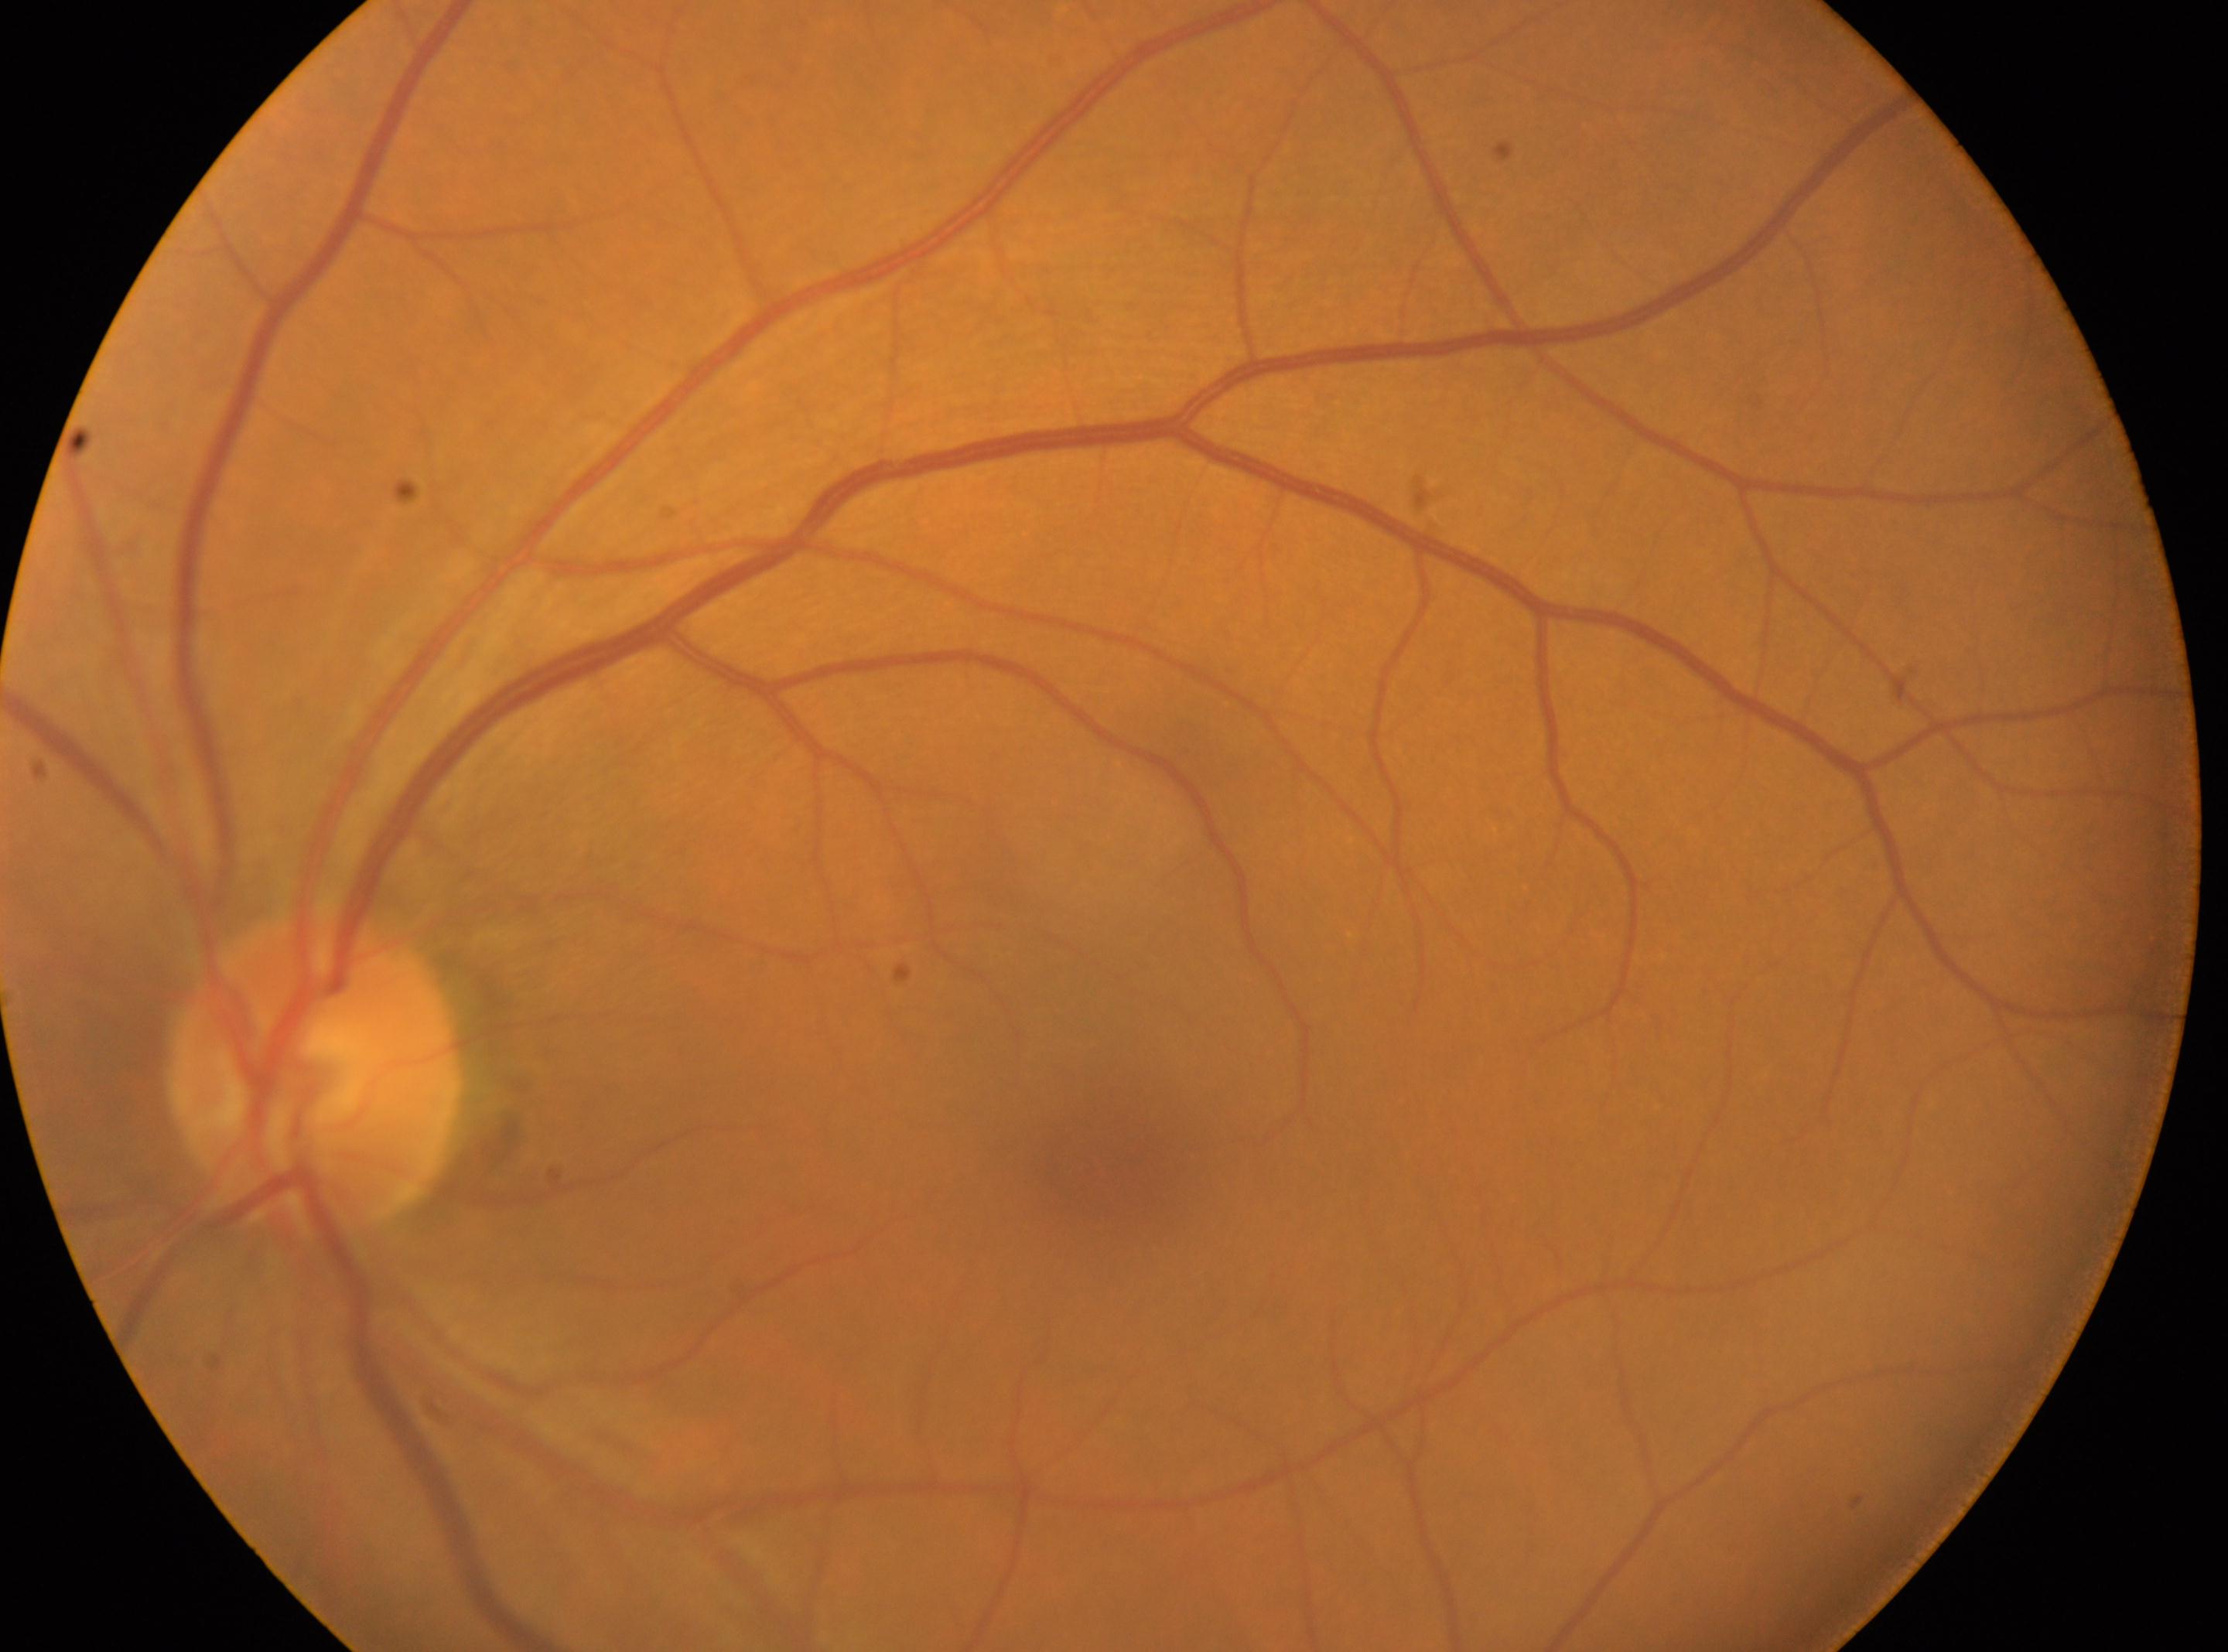 Diabetic retinopathy (DR): grade 0. Foveal center: (1103,1185). Optic disc center: (311,1070). No diabetic retinal disease findings. Eye: oculus sinister.